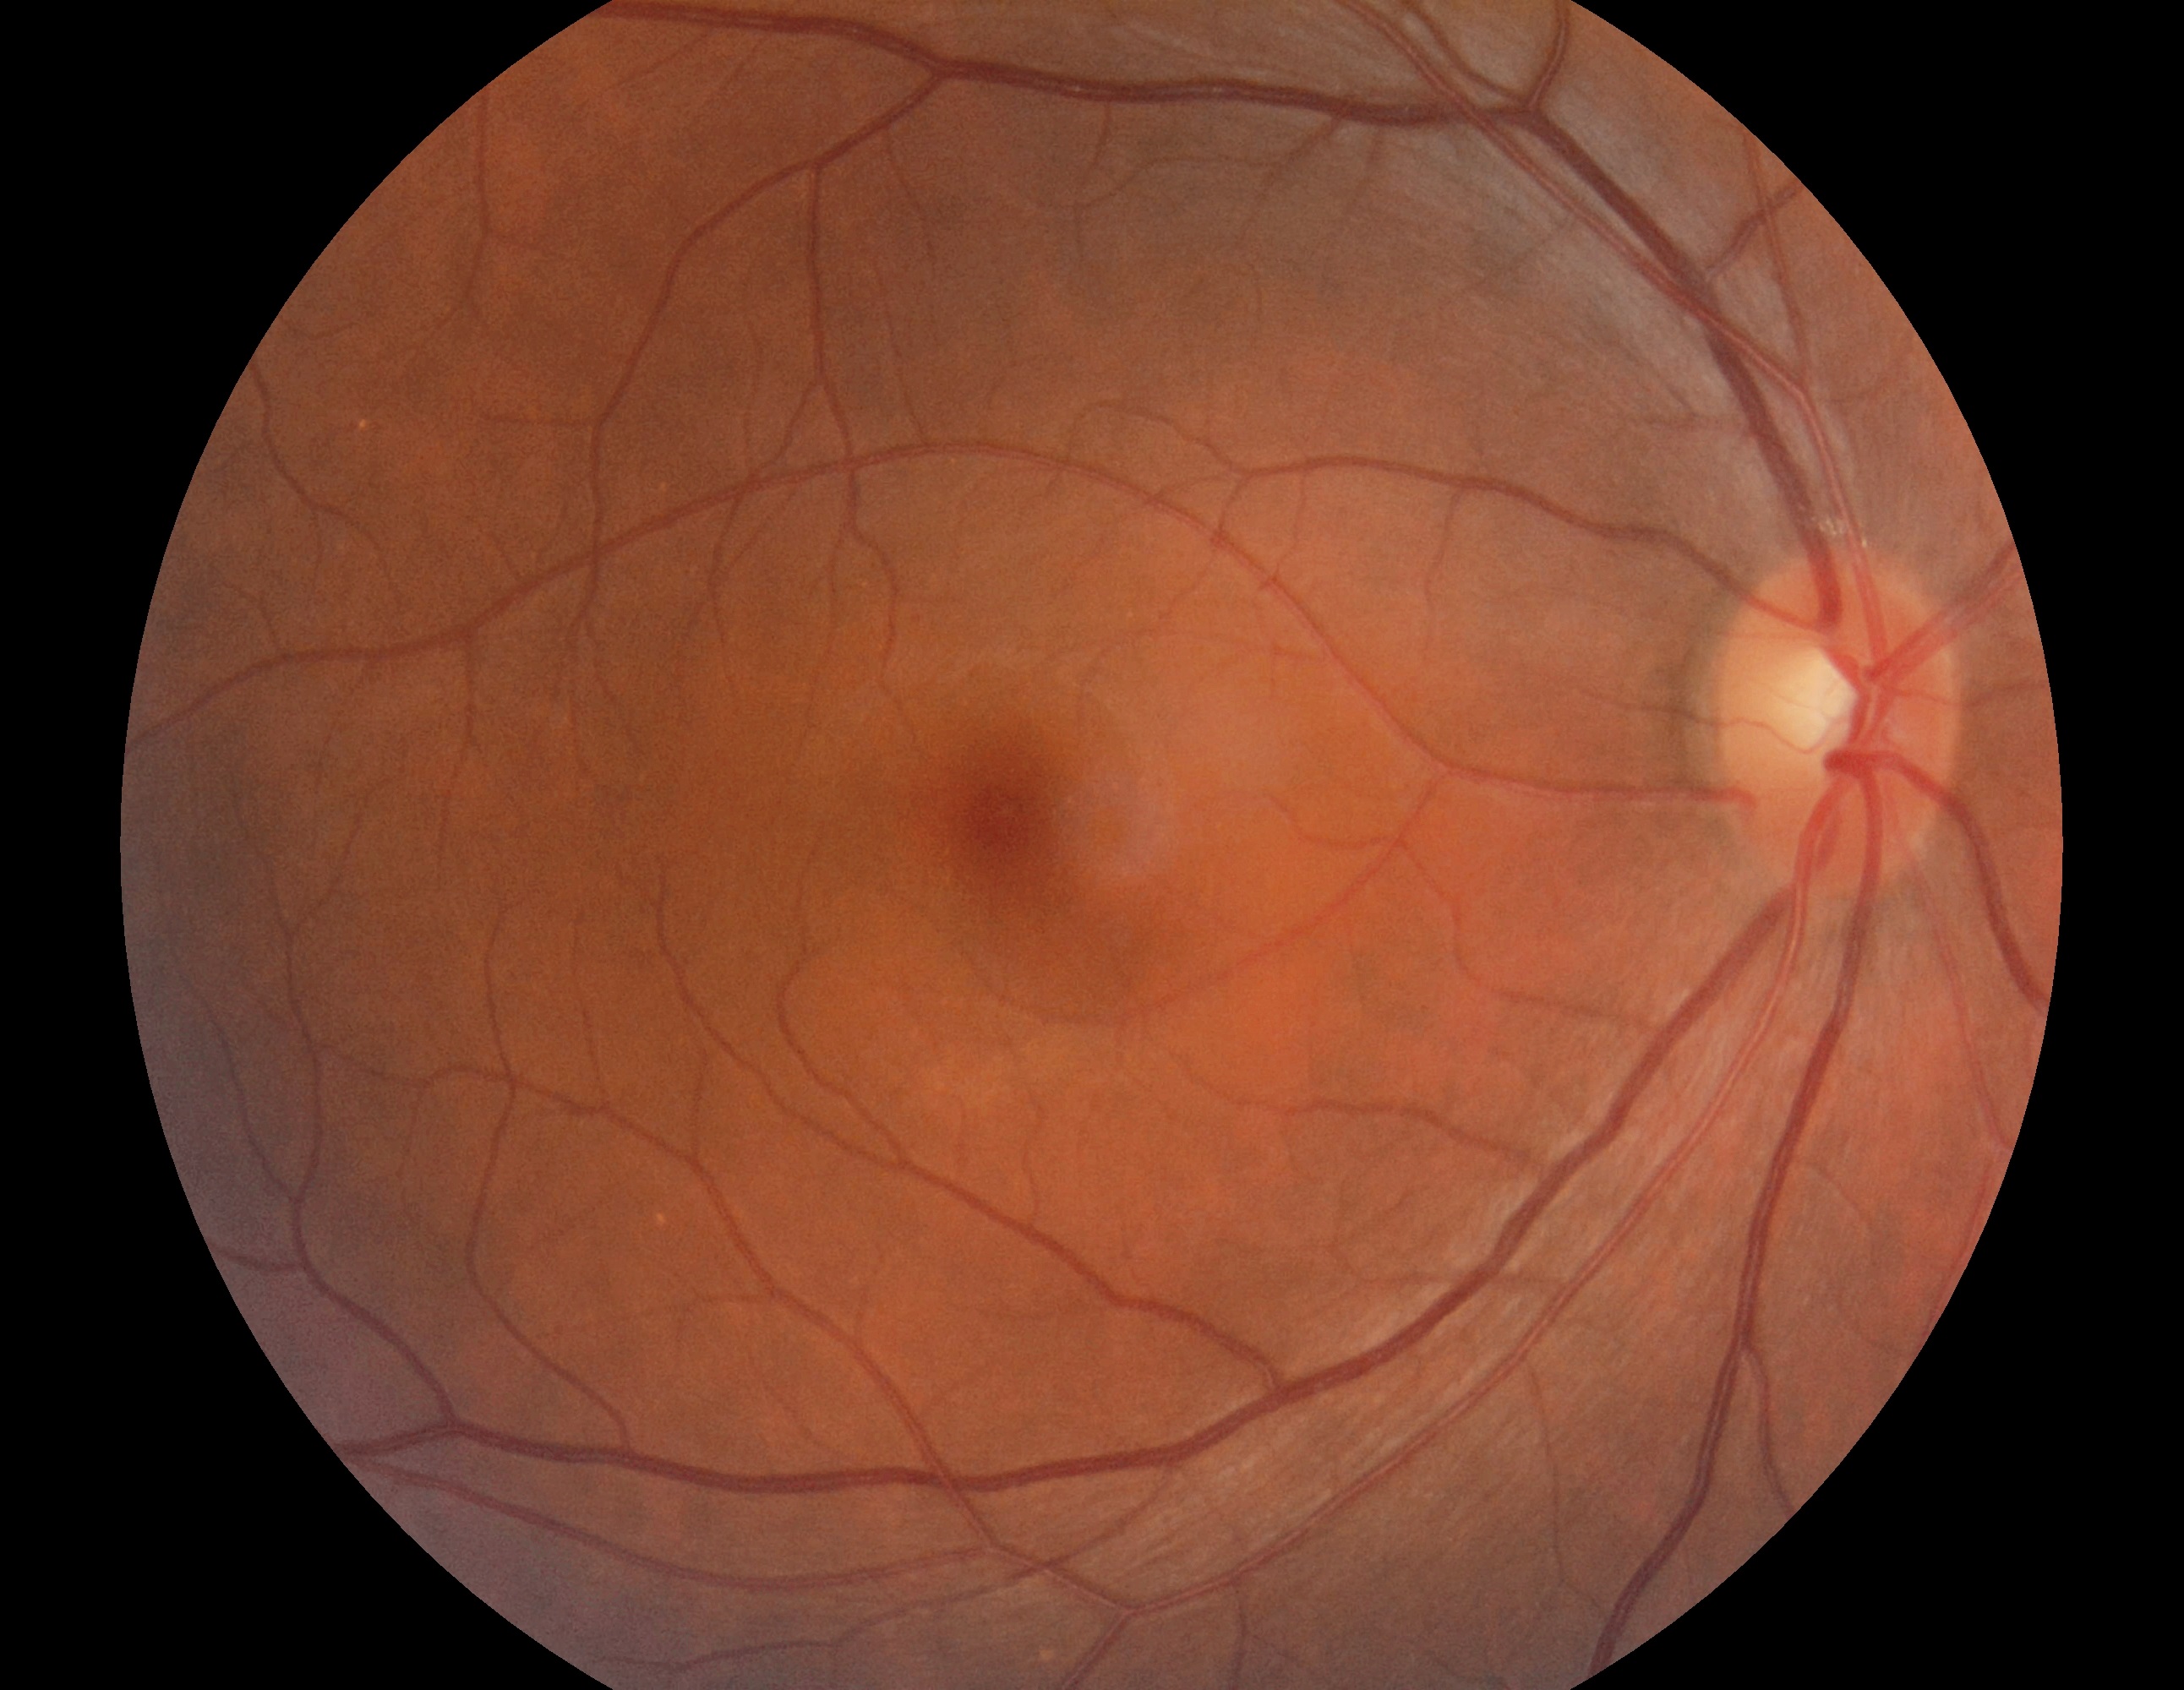
Diabetic retinopathy is grade 0 (no apparent retinopathy).